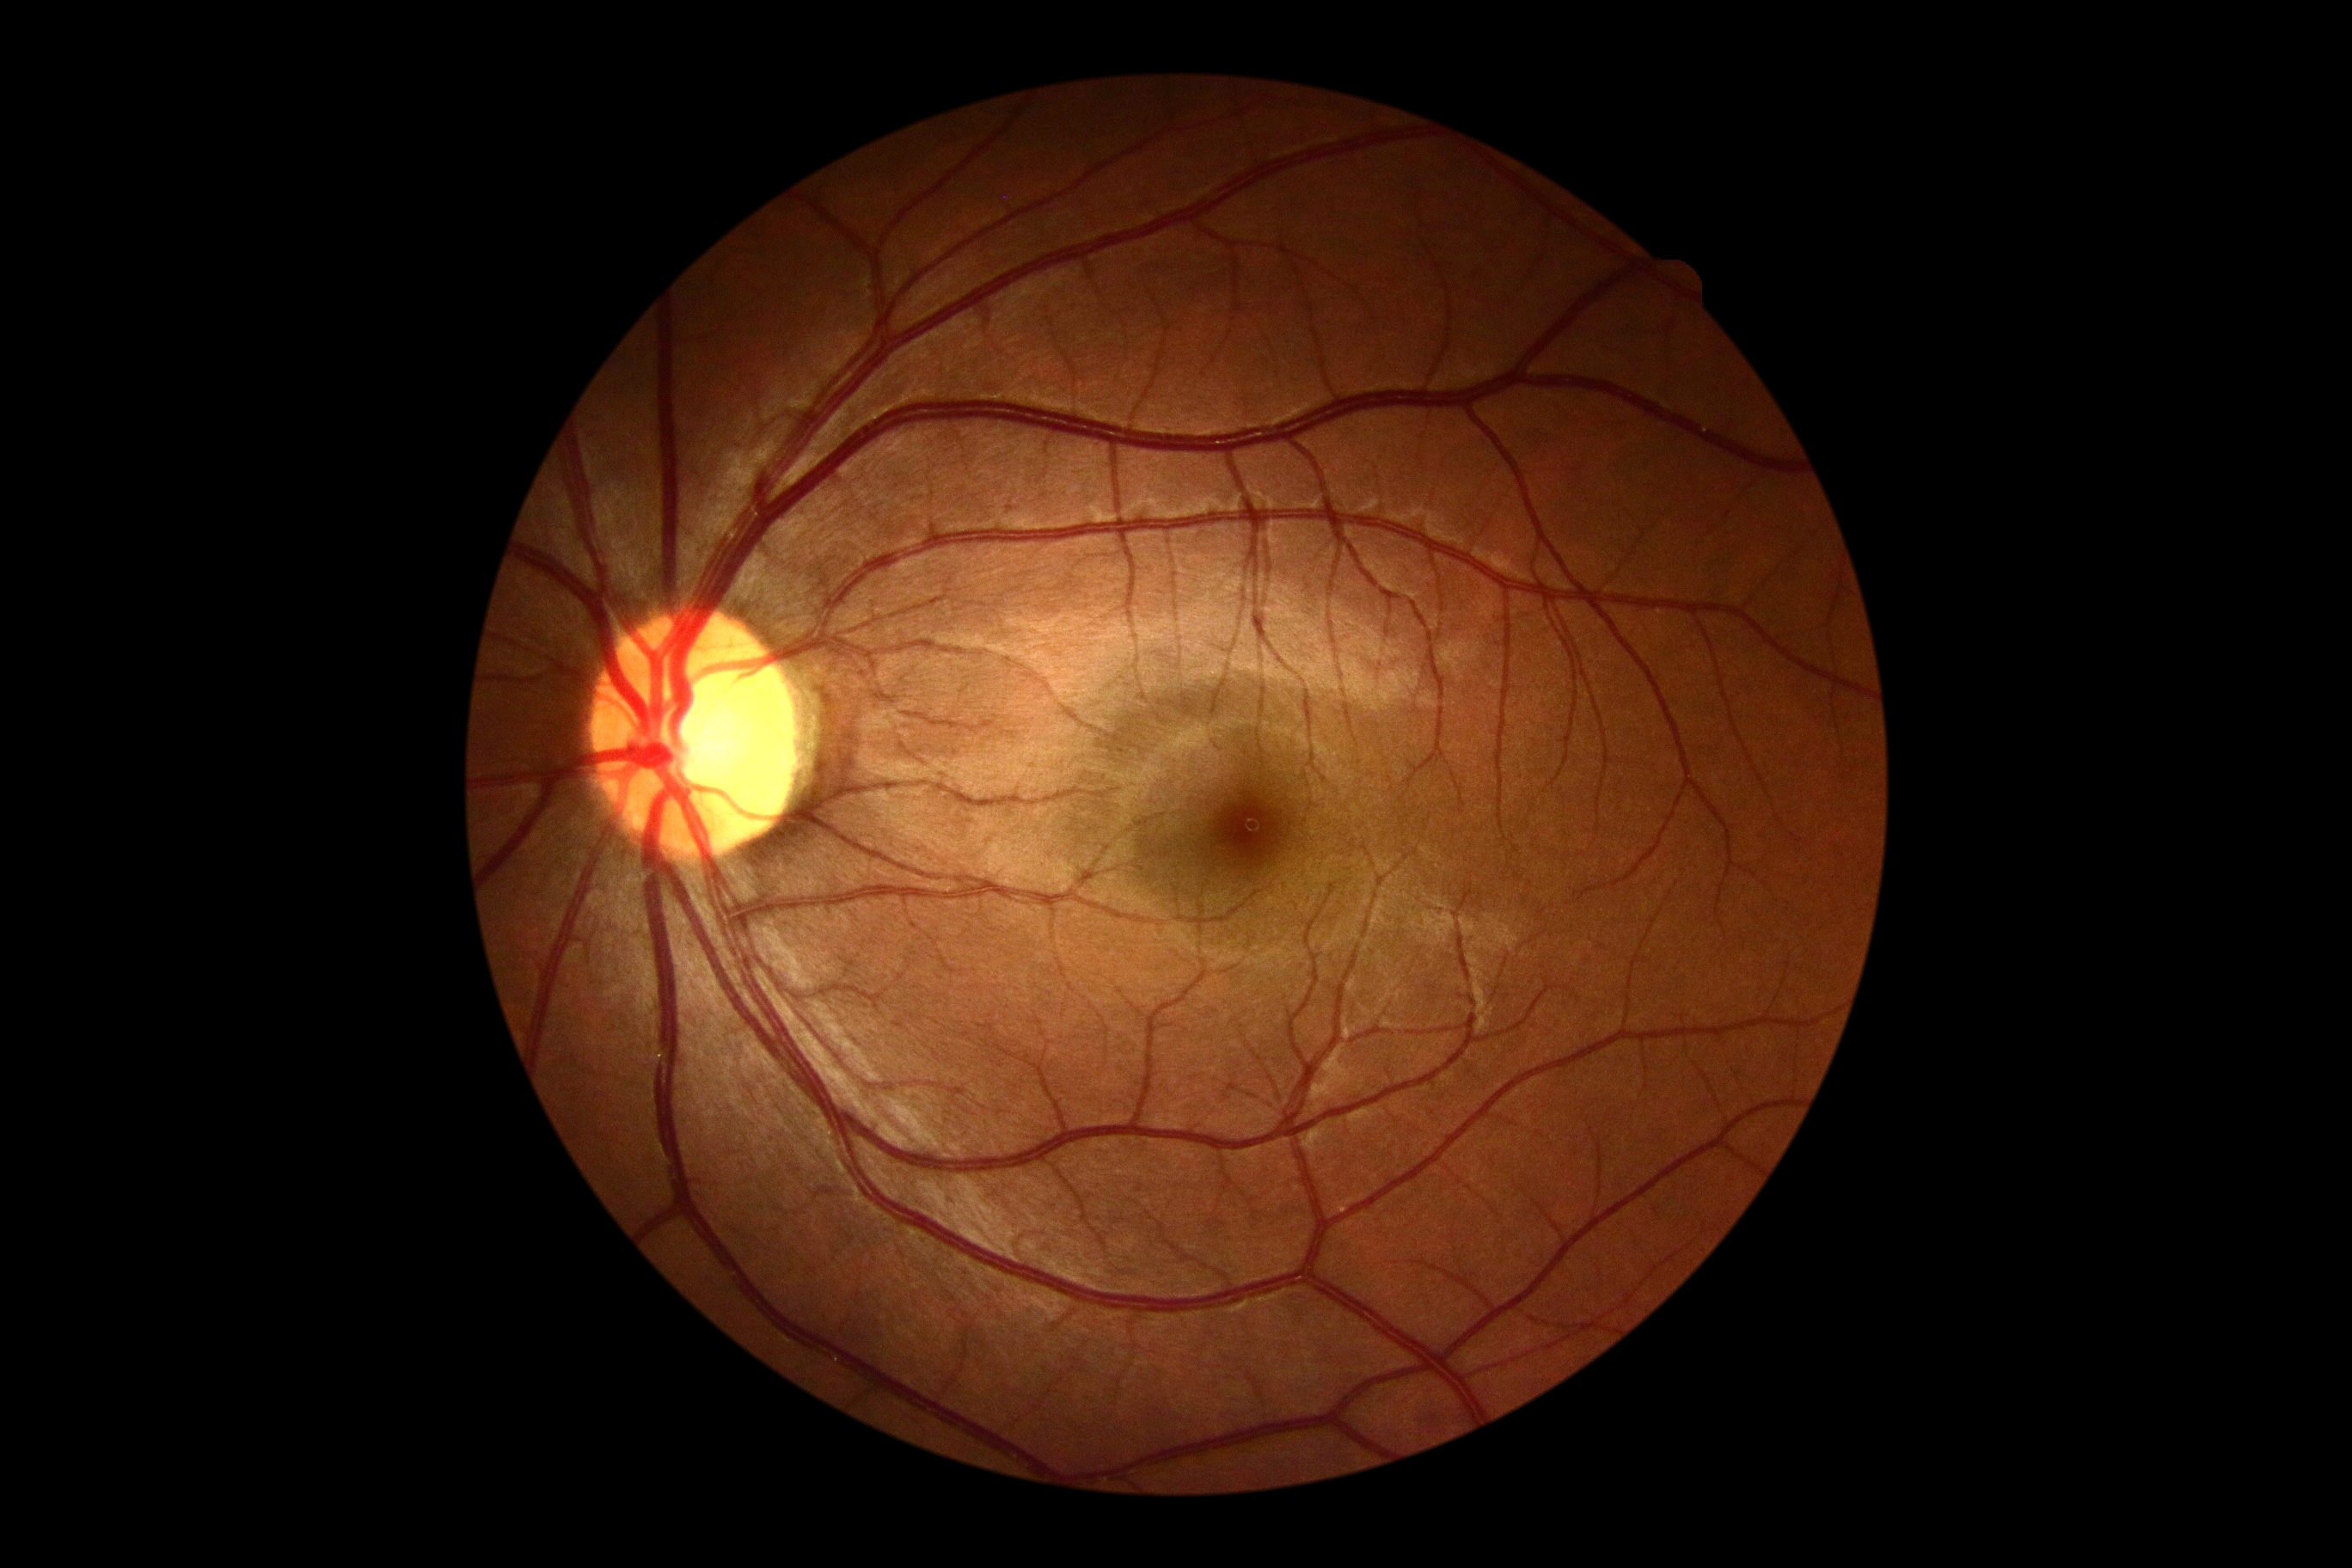

- DR stage: 0/4 — no visible signs of diabetic retinopathy